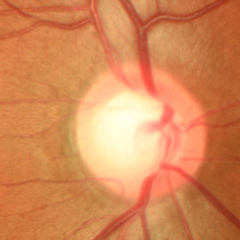 Showing no signs of glaucoma.